Wide-field fundus image from infant ROP screening — 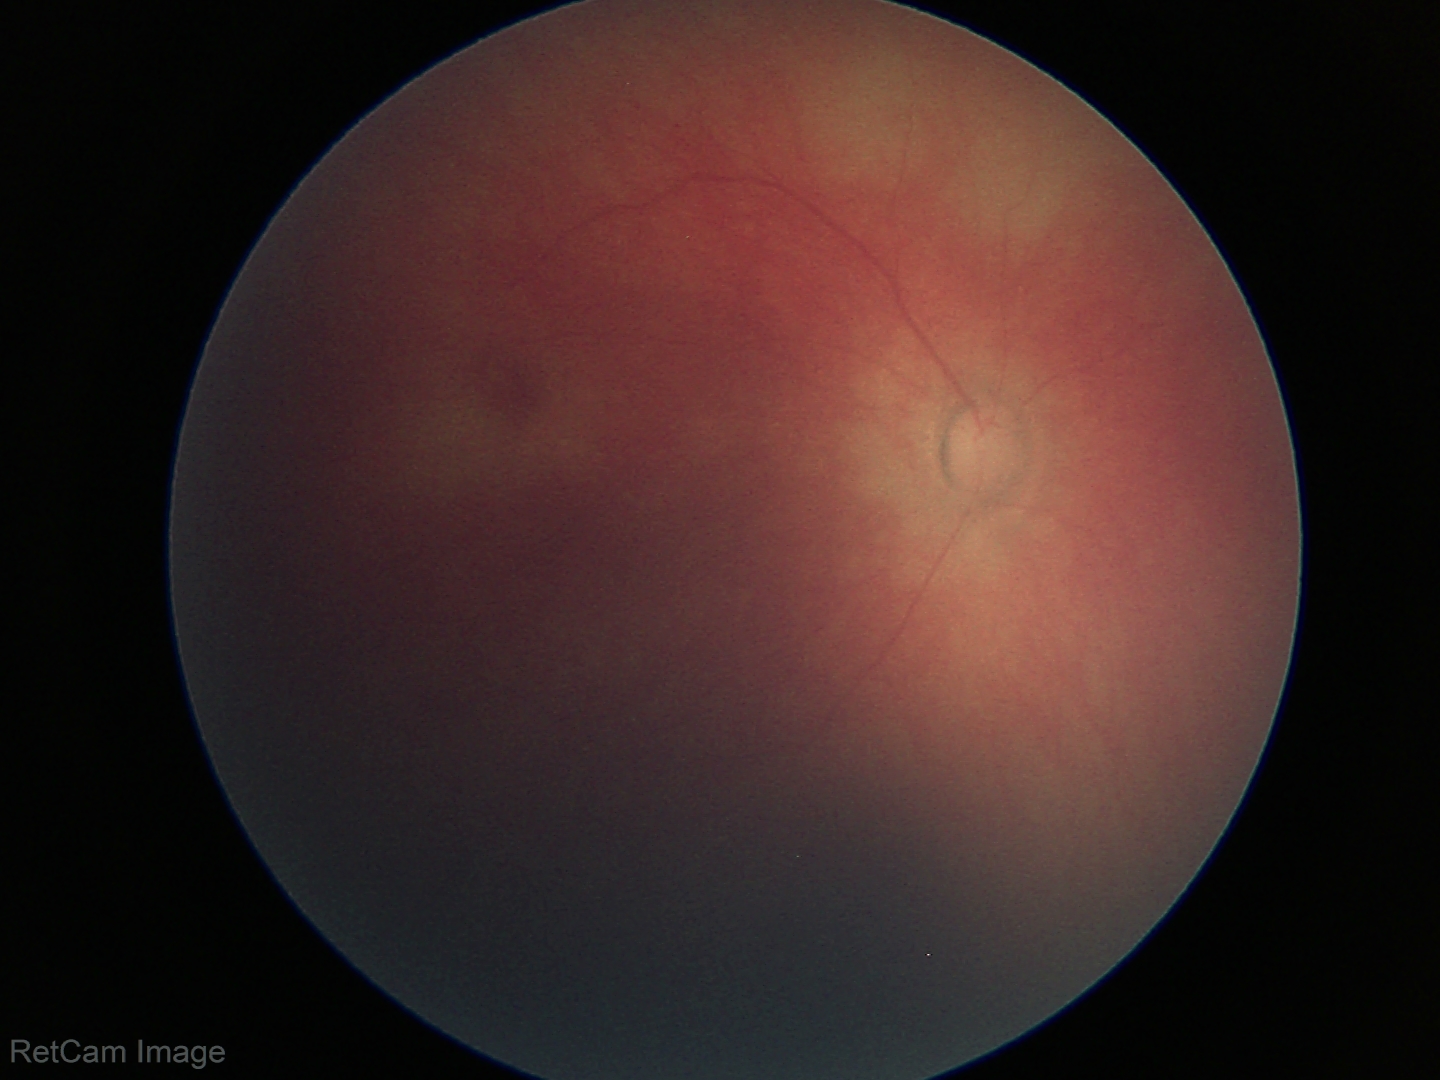 Examination with physiological retinal findings.